240x240px:
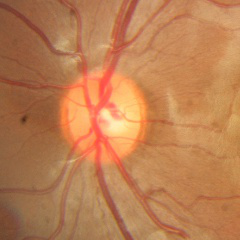

Assessment = no glaucomatous changes.